412x310px; color fundus image.
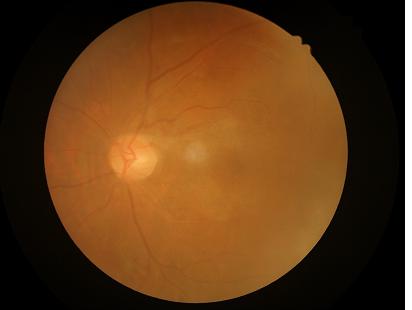
Overall image quality is poor. Out of focus; structures are indistinct. Adequate contrast for distinguishing structures. Illumination and color balance are good.